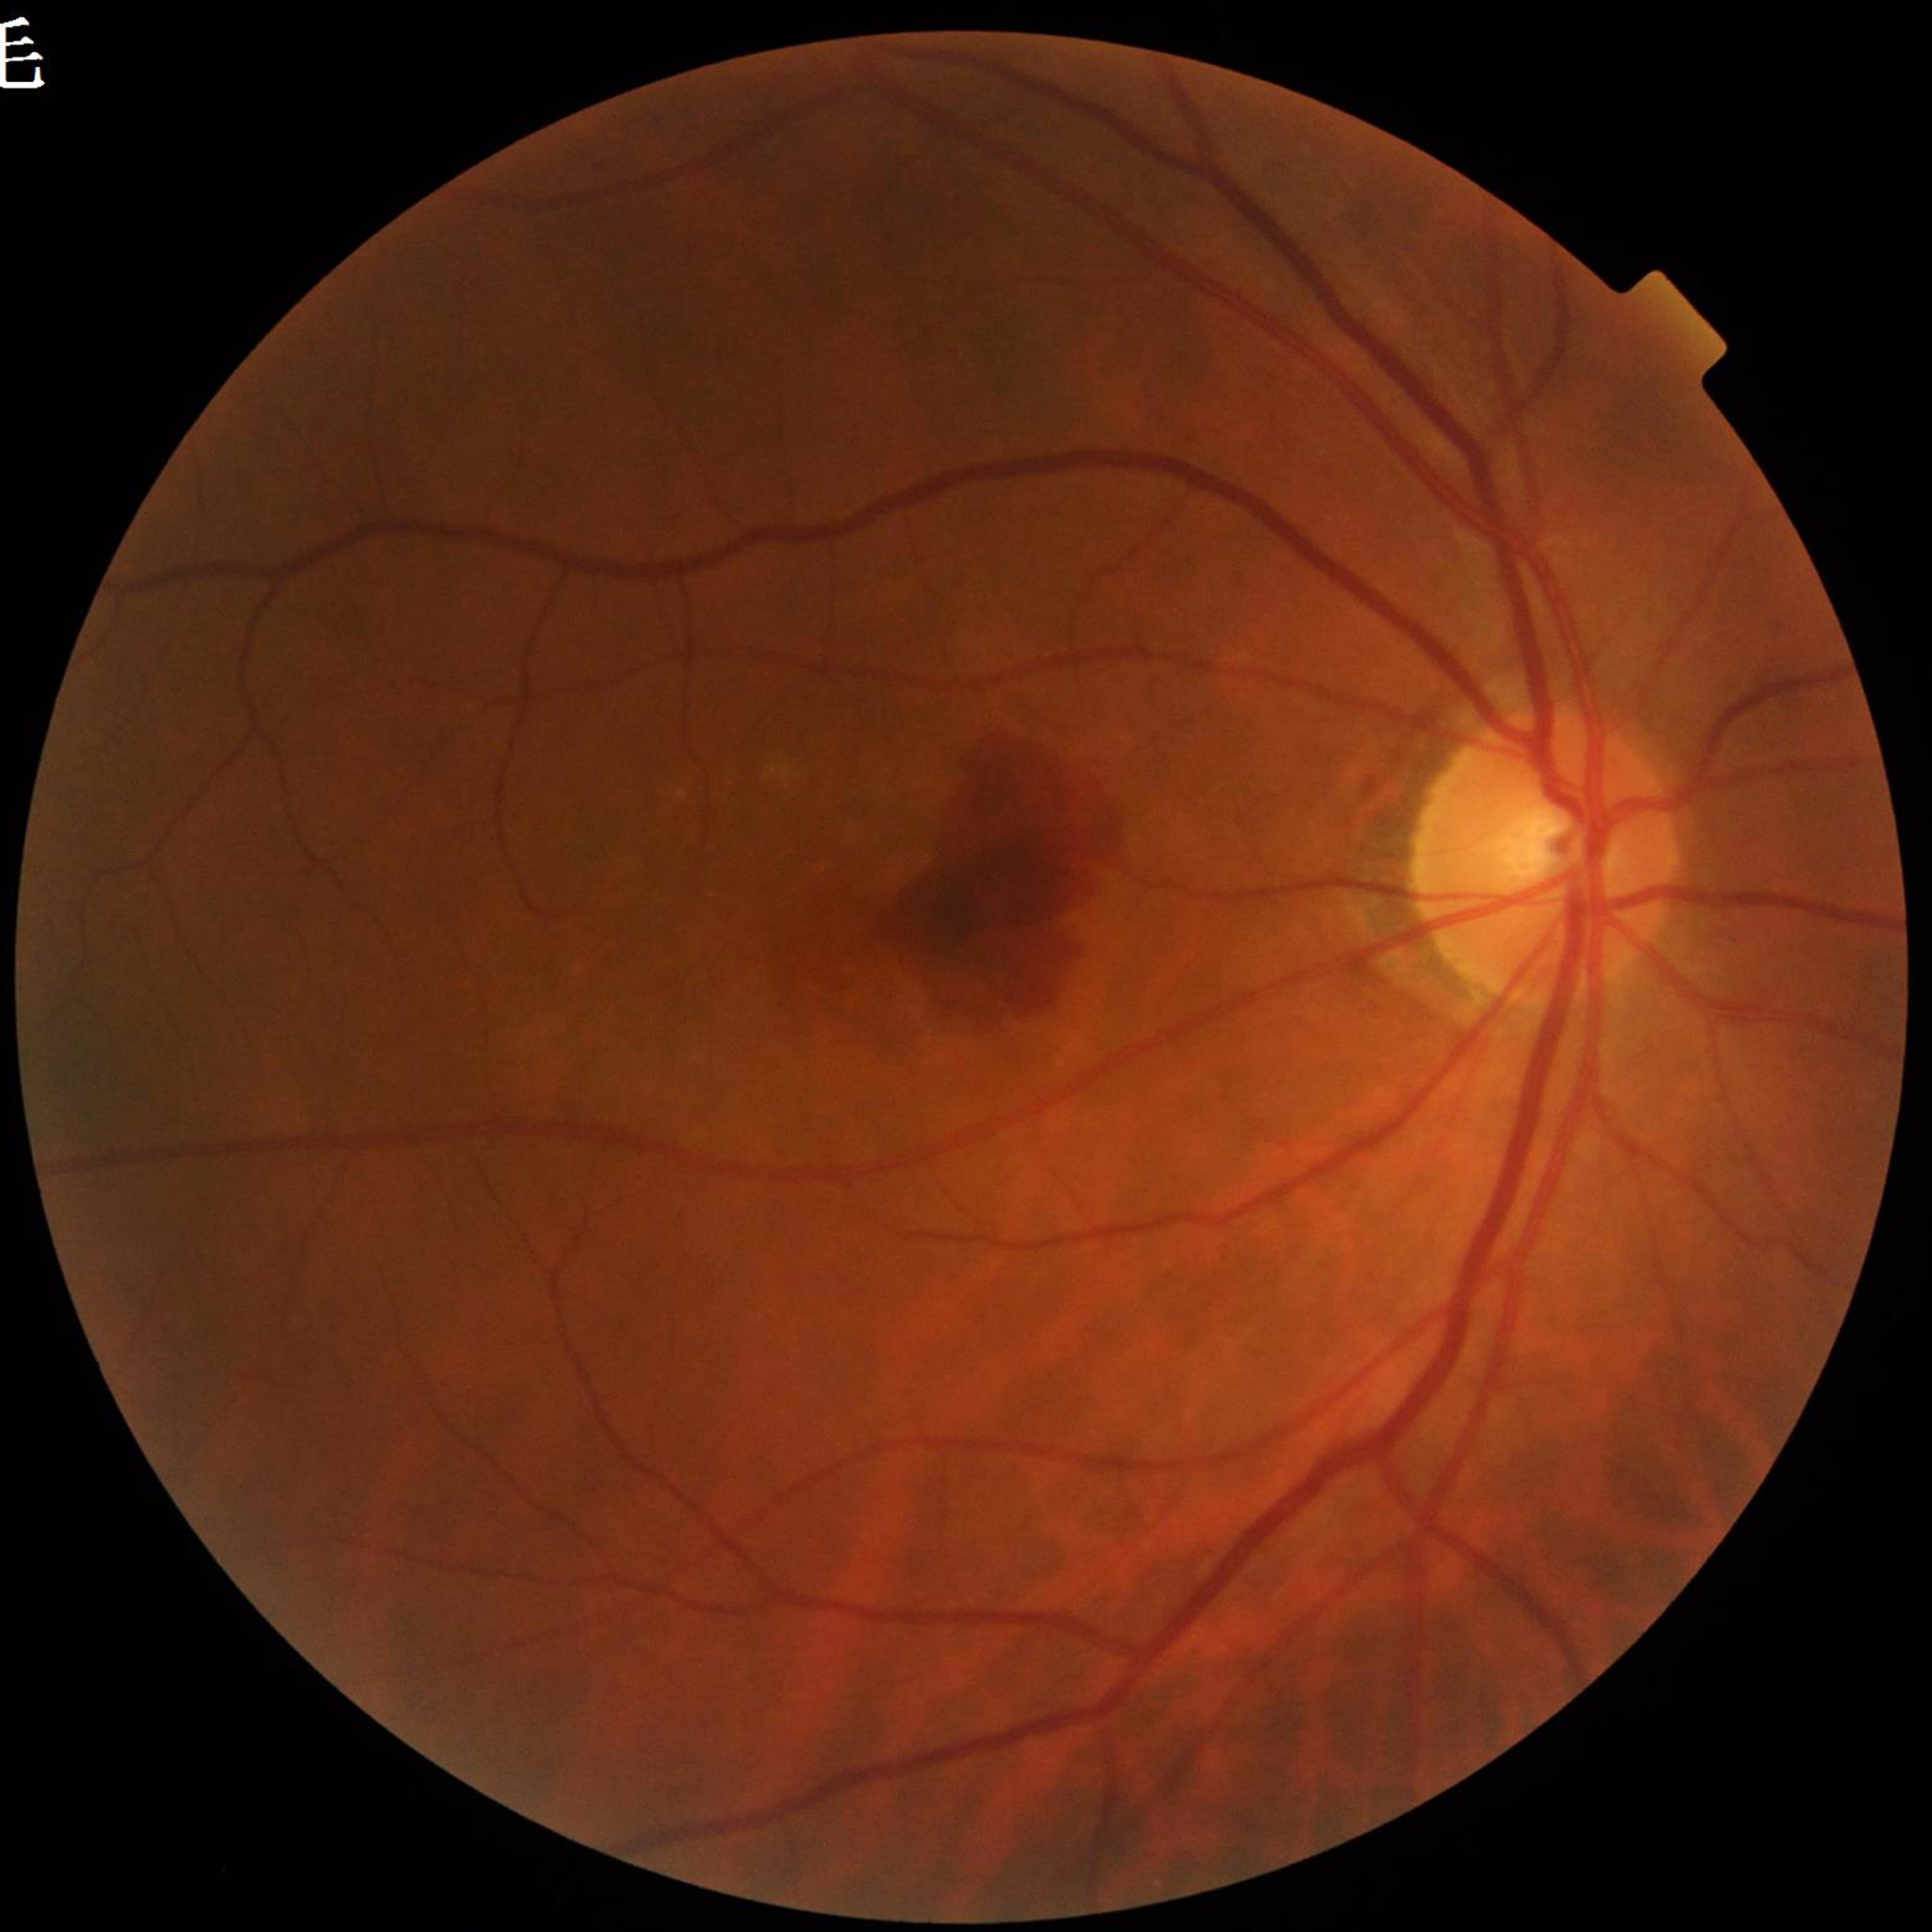

  diagnosis: AMD